Image size 1240x1240; wide-field fundus photograph of an infant:
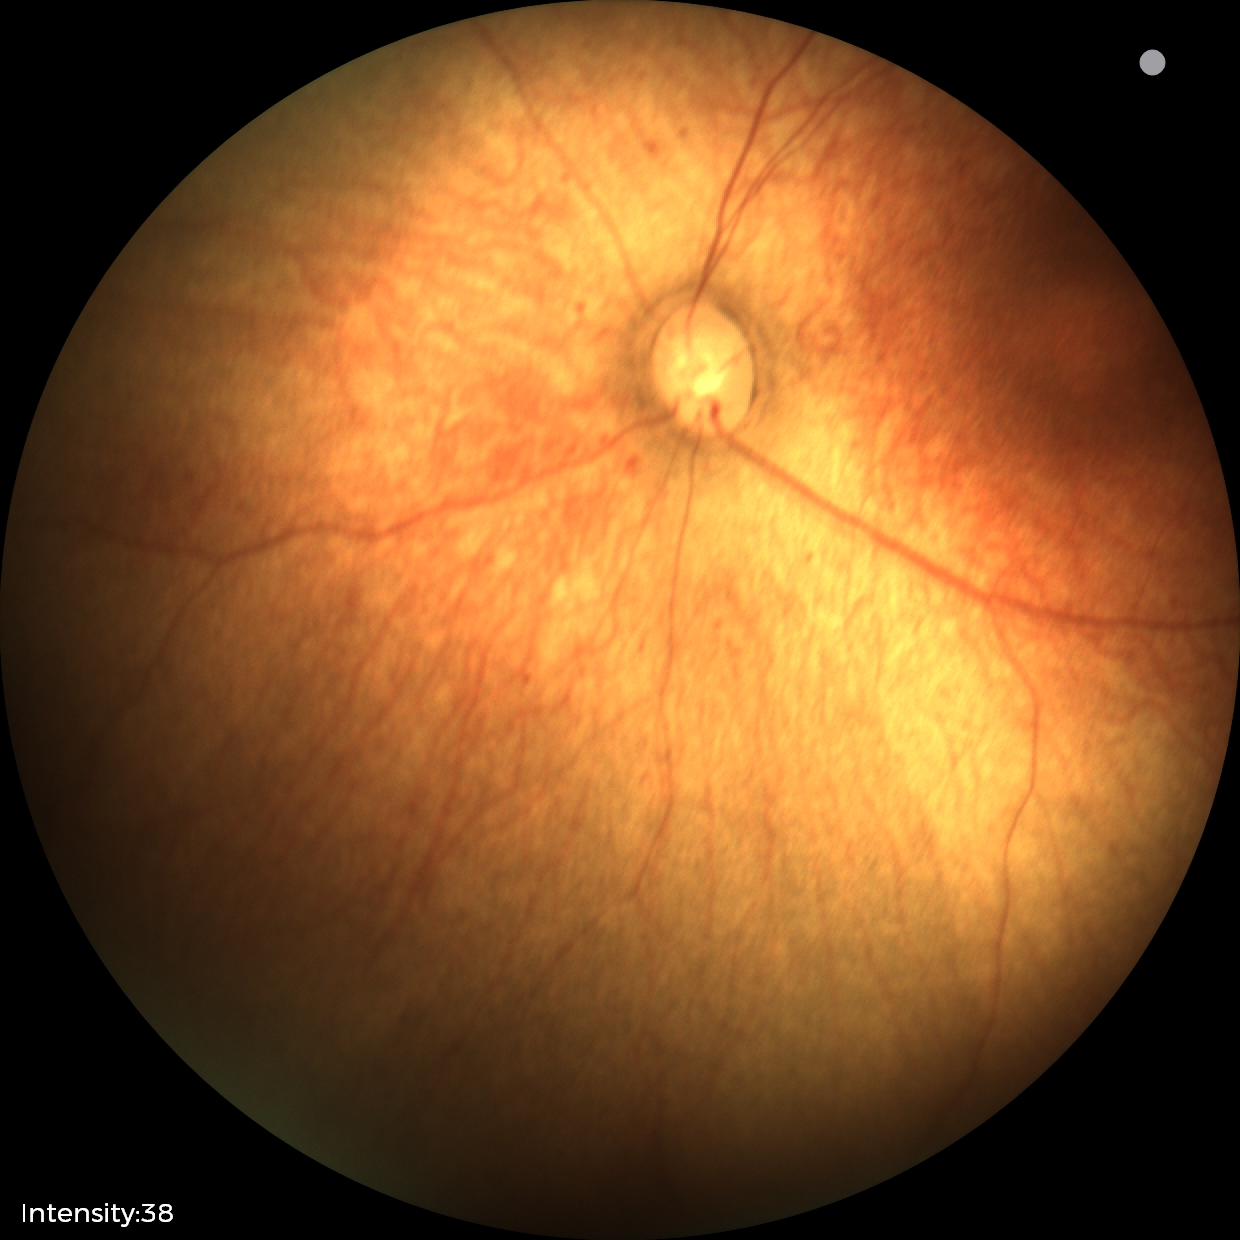 Impression: physiological appearance